Camera: NIDEK AFC-230, 45° field of view, nonmydriatic fundus photograph, 848 by 848 pixels, modified Davis grading
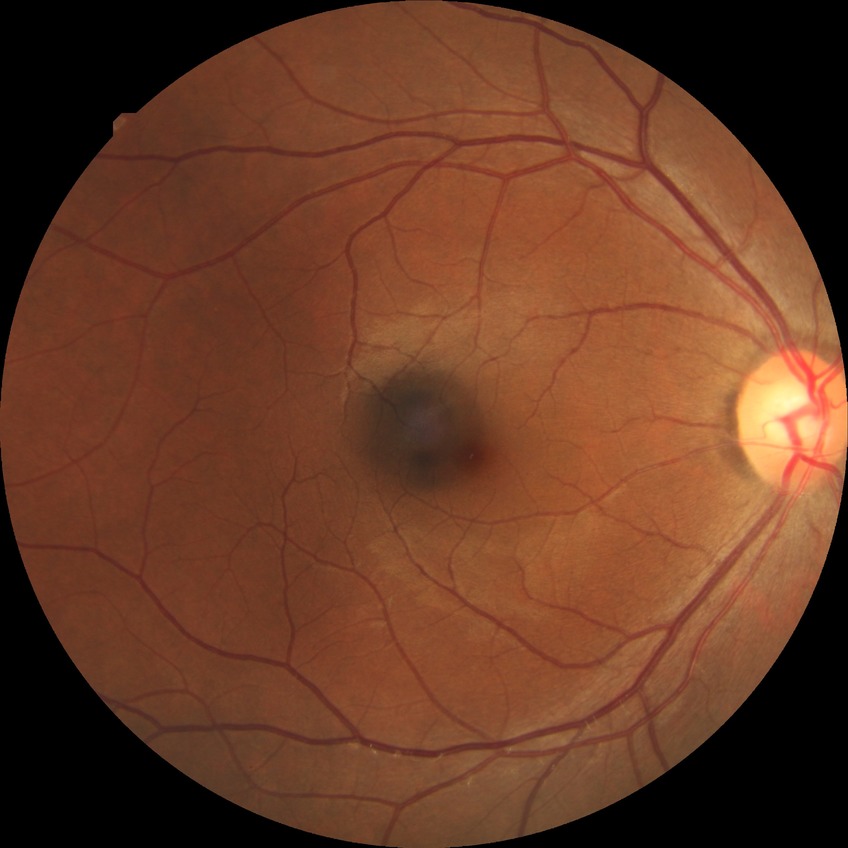 Diabetic retinopathy (DR) is no diabetic retinopathy (NDR).